Color fundus photograph. Without pupil dilation. Image size 848x848: 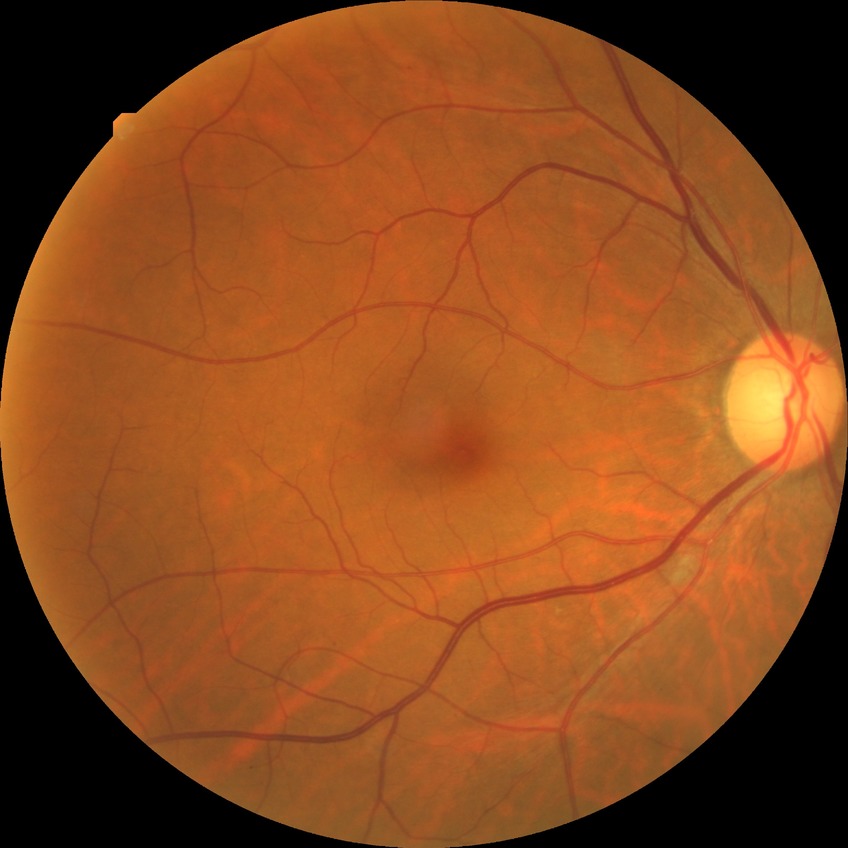

• retinopathy grade — simple diabetic retinopathy